Davis DR grading, image size 848x848, fundus photo, acquired with a NIDEK AFC-230
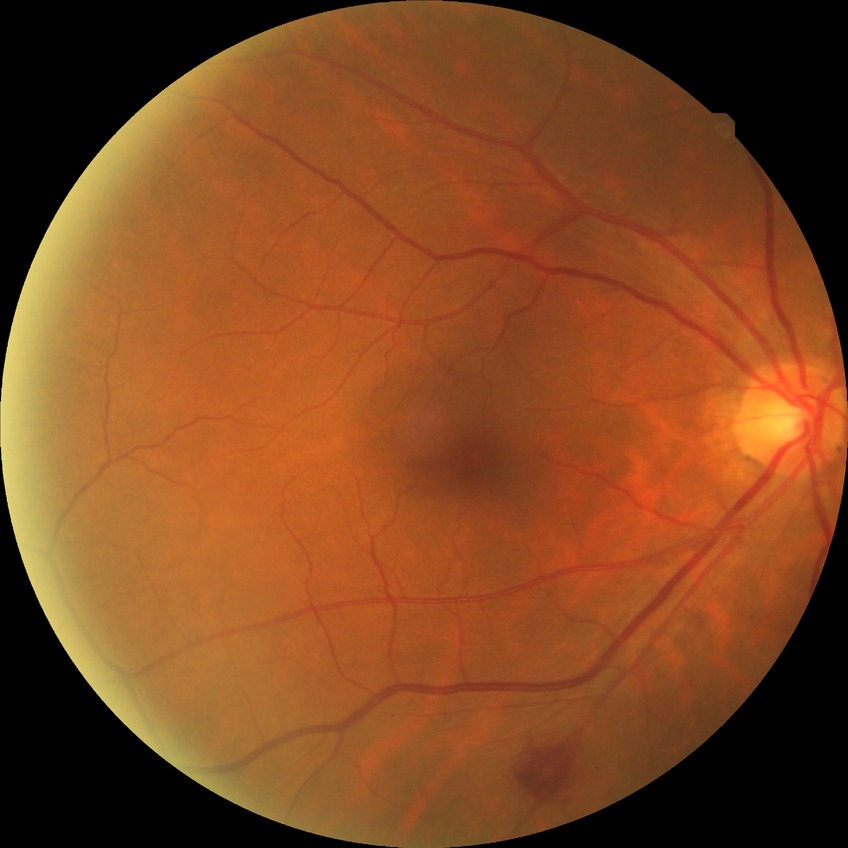
Retinopathy grade: no diabetic retinopathy.